Image size 1440x1080. Pediatric wide-field fundus photograph. Acquired on the Natus RetCam Envision.
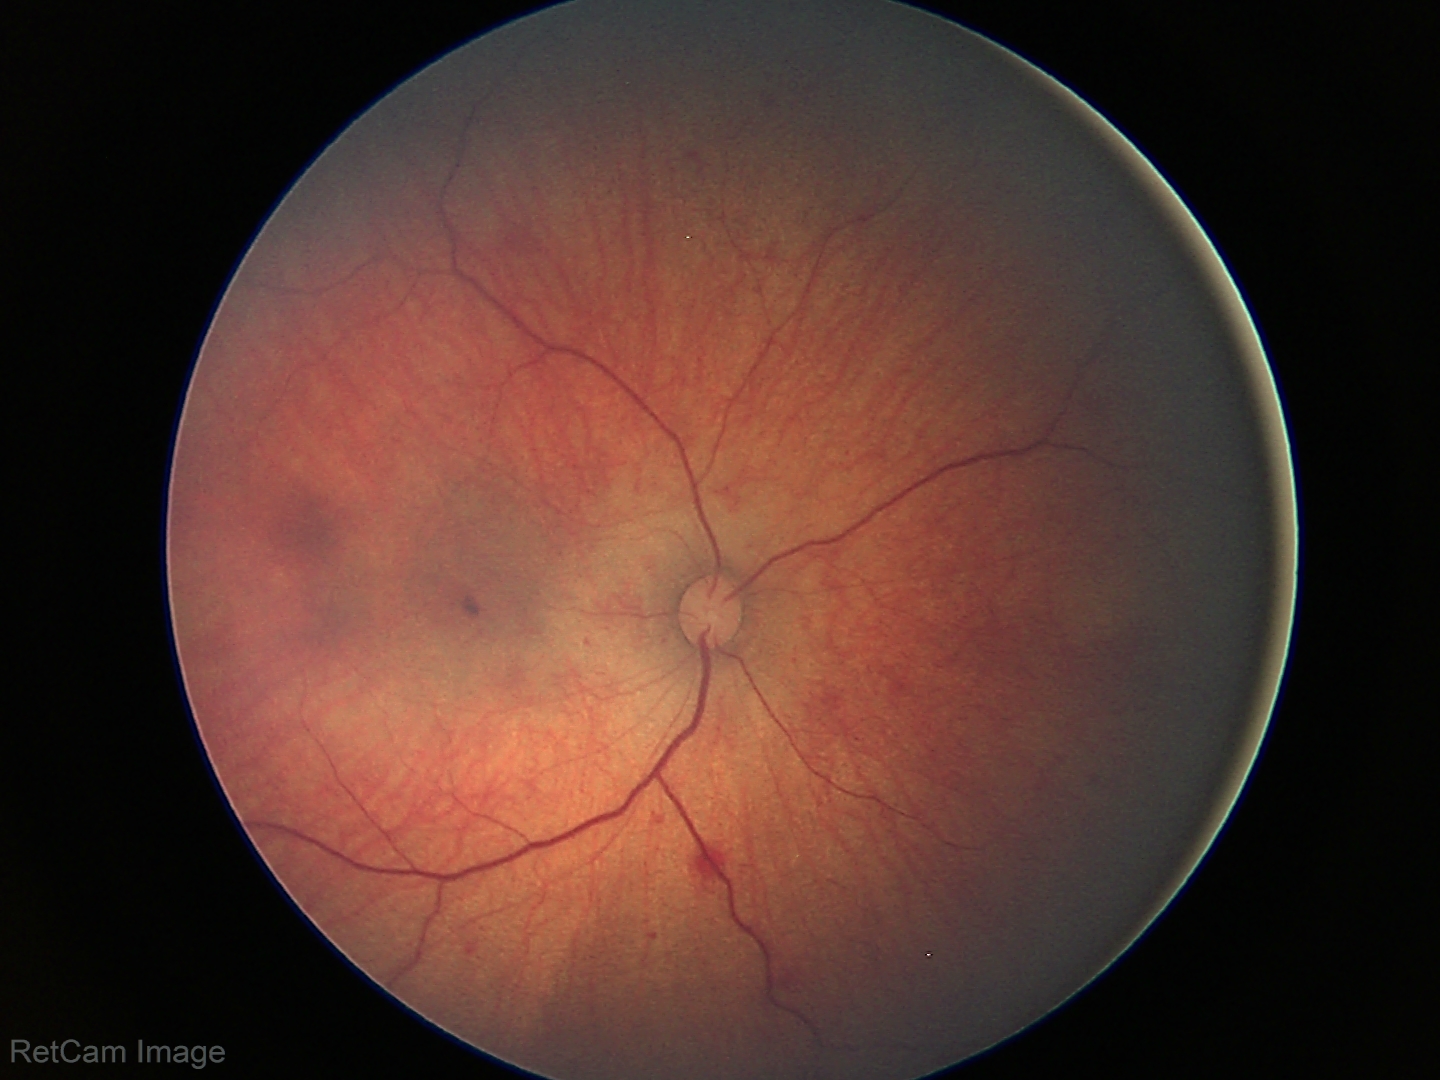 Q: What is the screening diagnosis?
A: retinal hemorrhages